Pediatric wide-field fundus photograph.
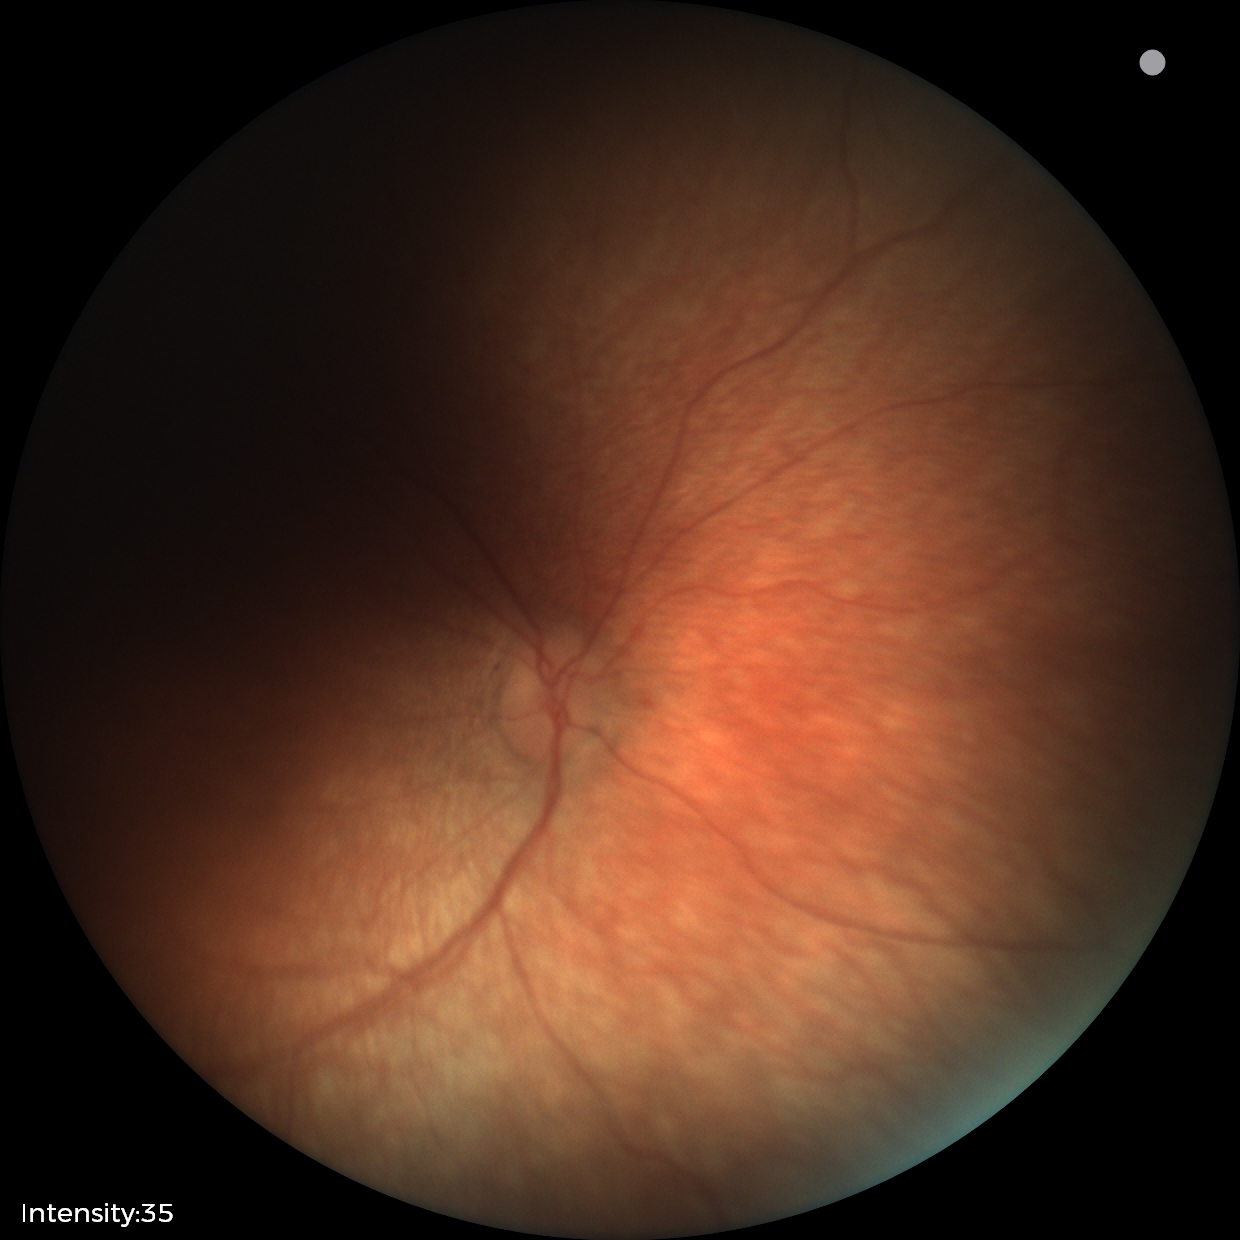 Physiological retinal appearance for postconceptual age.